848 by 848 pixels, FOV: 45 degrees, CFP, NIDEK AFC-230
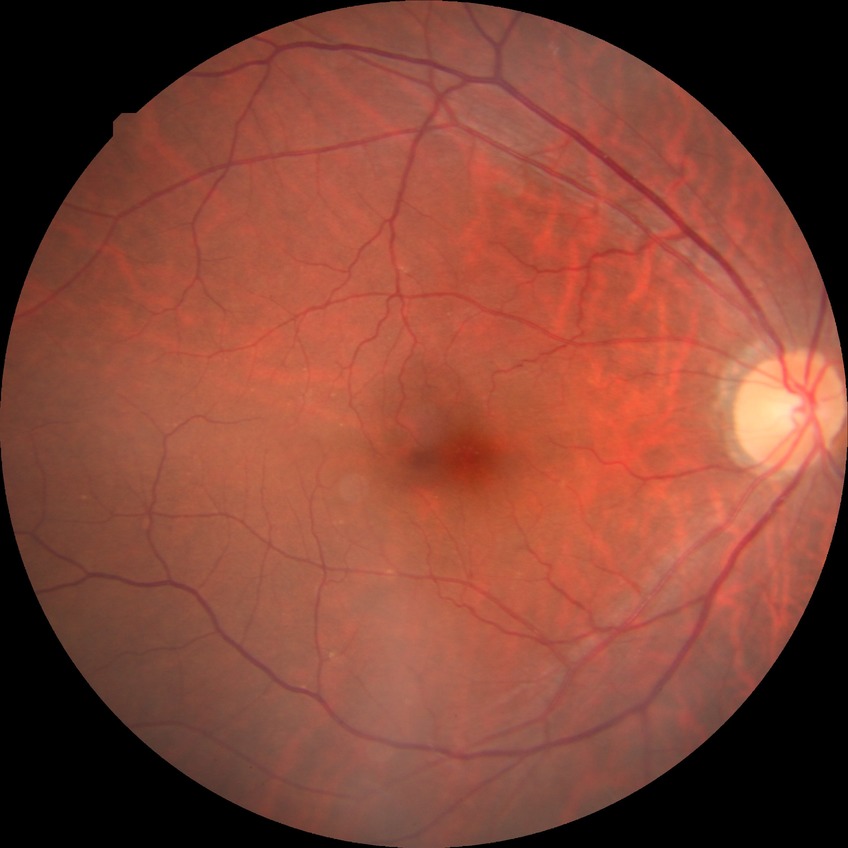 Diabetic retinopathy (DR): NDR (no diabetic retinopathy).